UWF retinal mosaic. 200-degree field of view. 1924 by 1556 pixels — 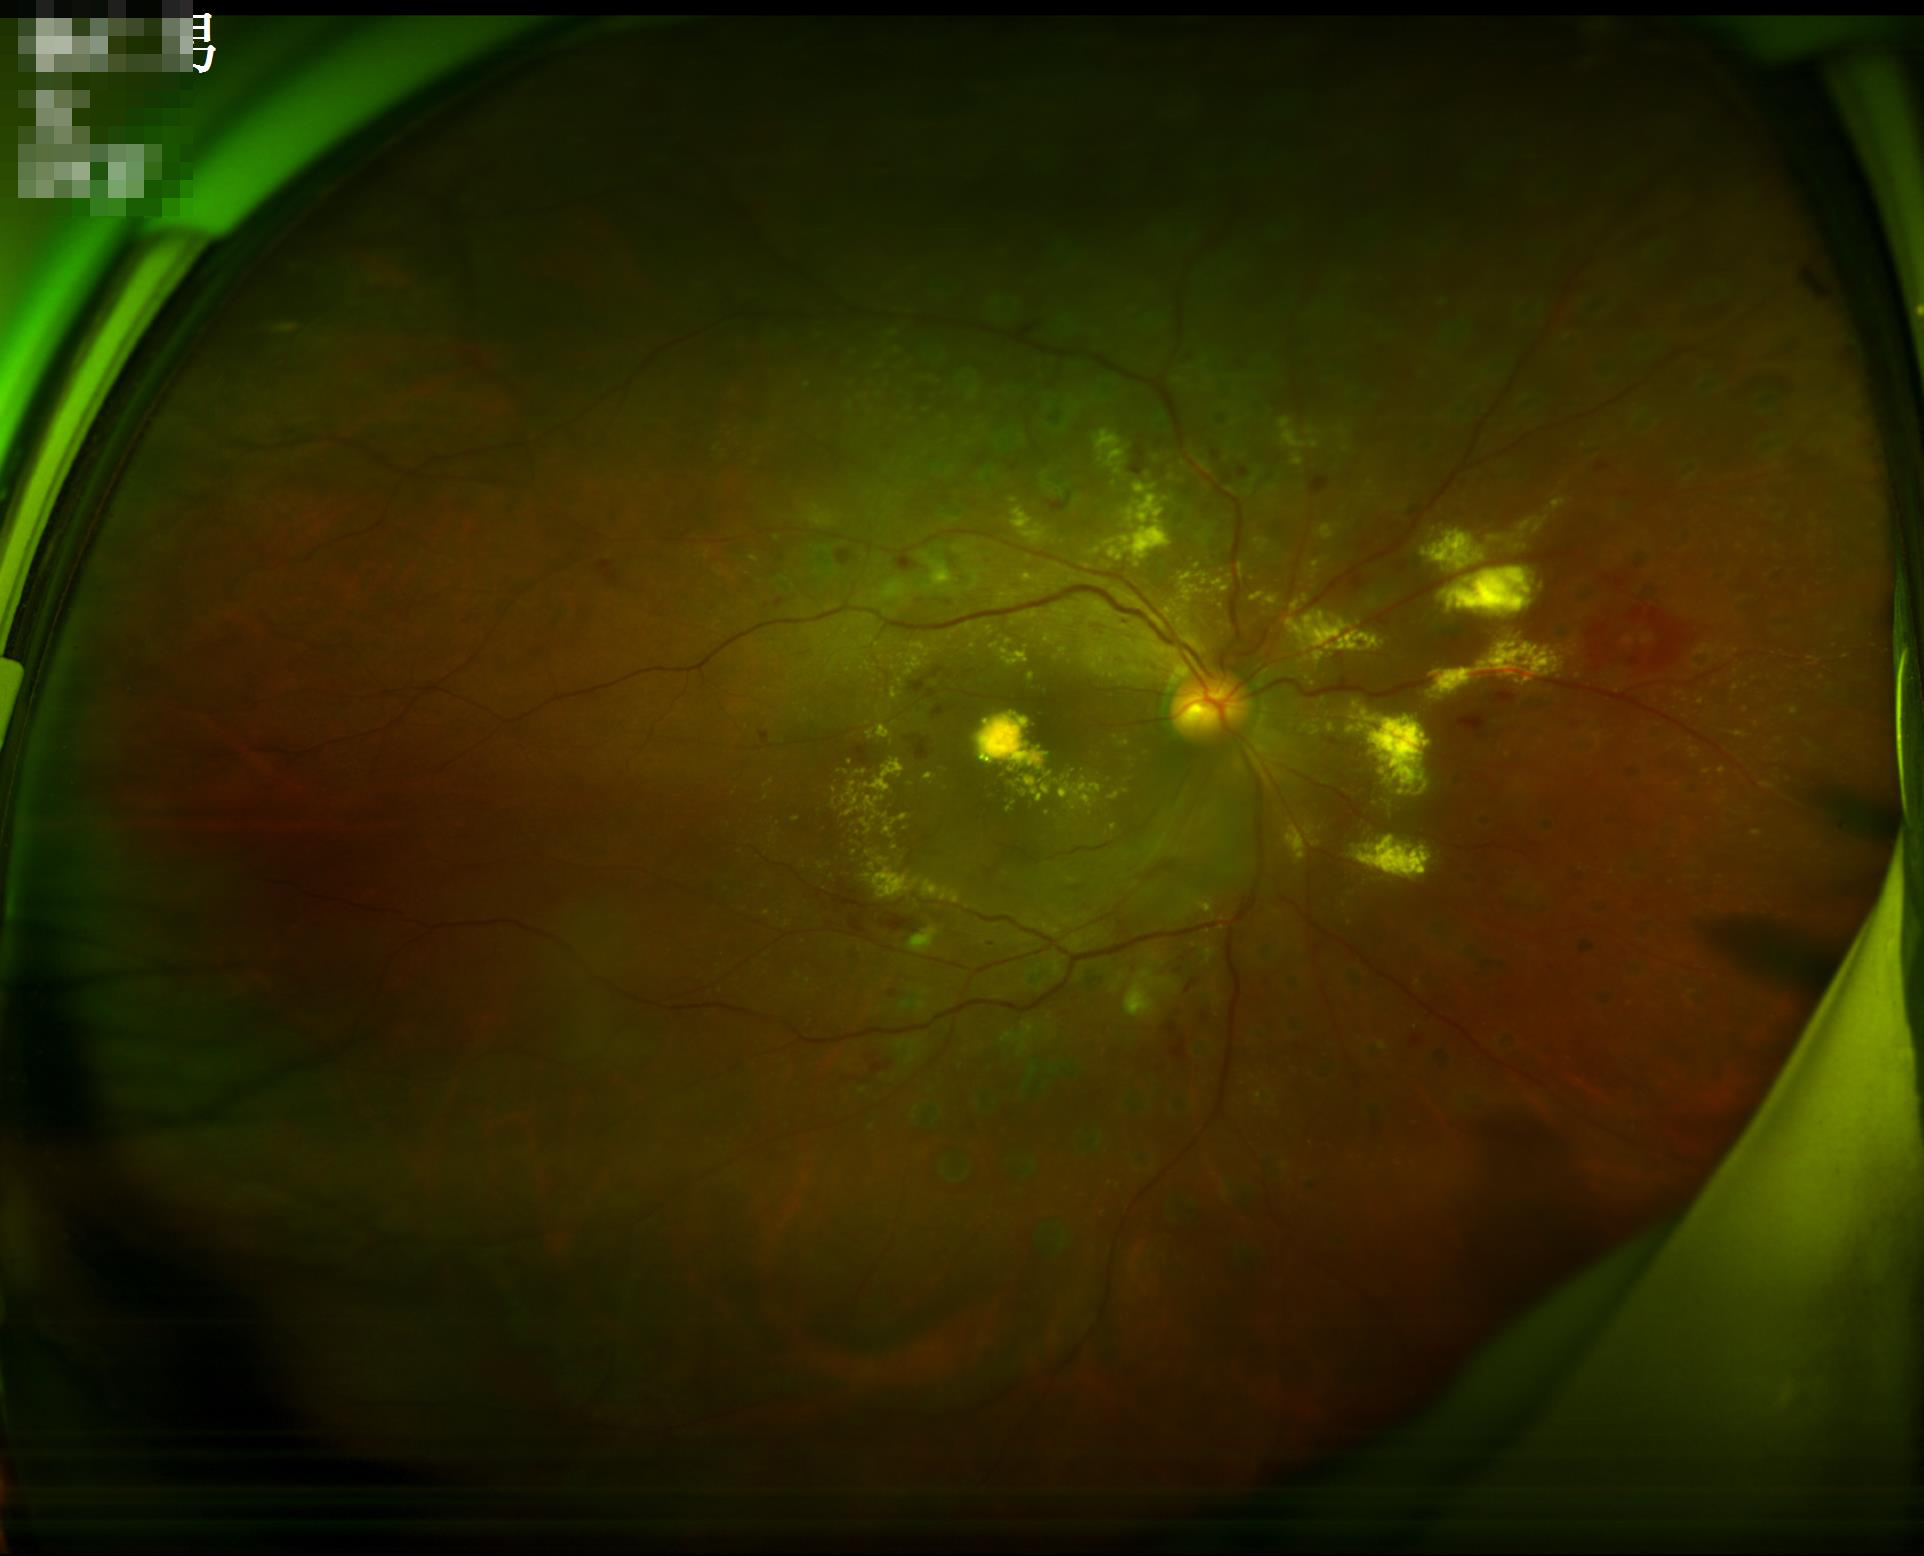 Illumination is uneven. Optic disc, vessels, and background are in focus. Overall image quality is good.